Camera: Topcon TRC-NW8 · retinal fundus photograph: 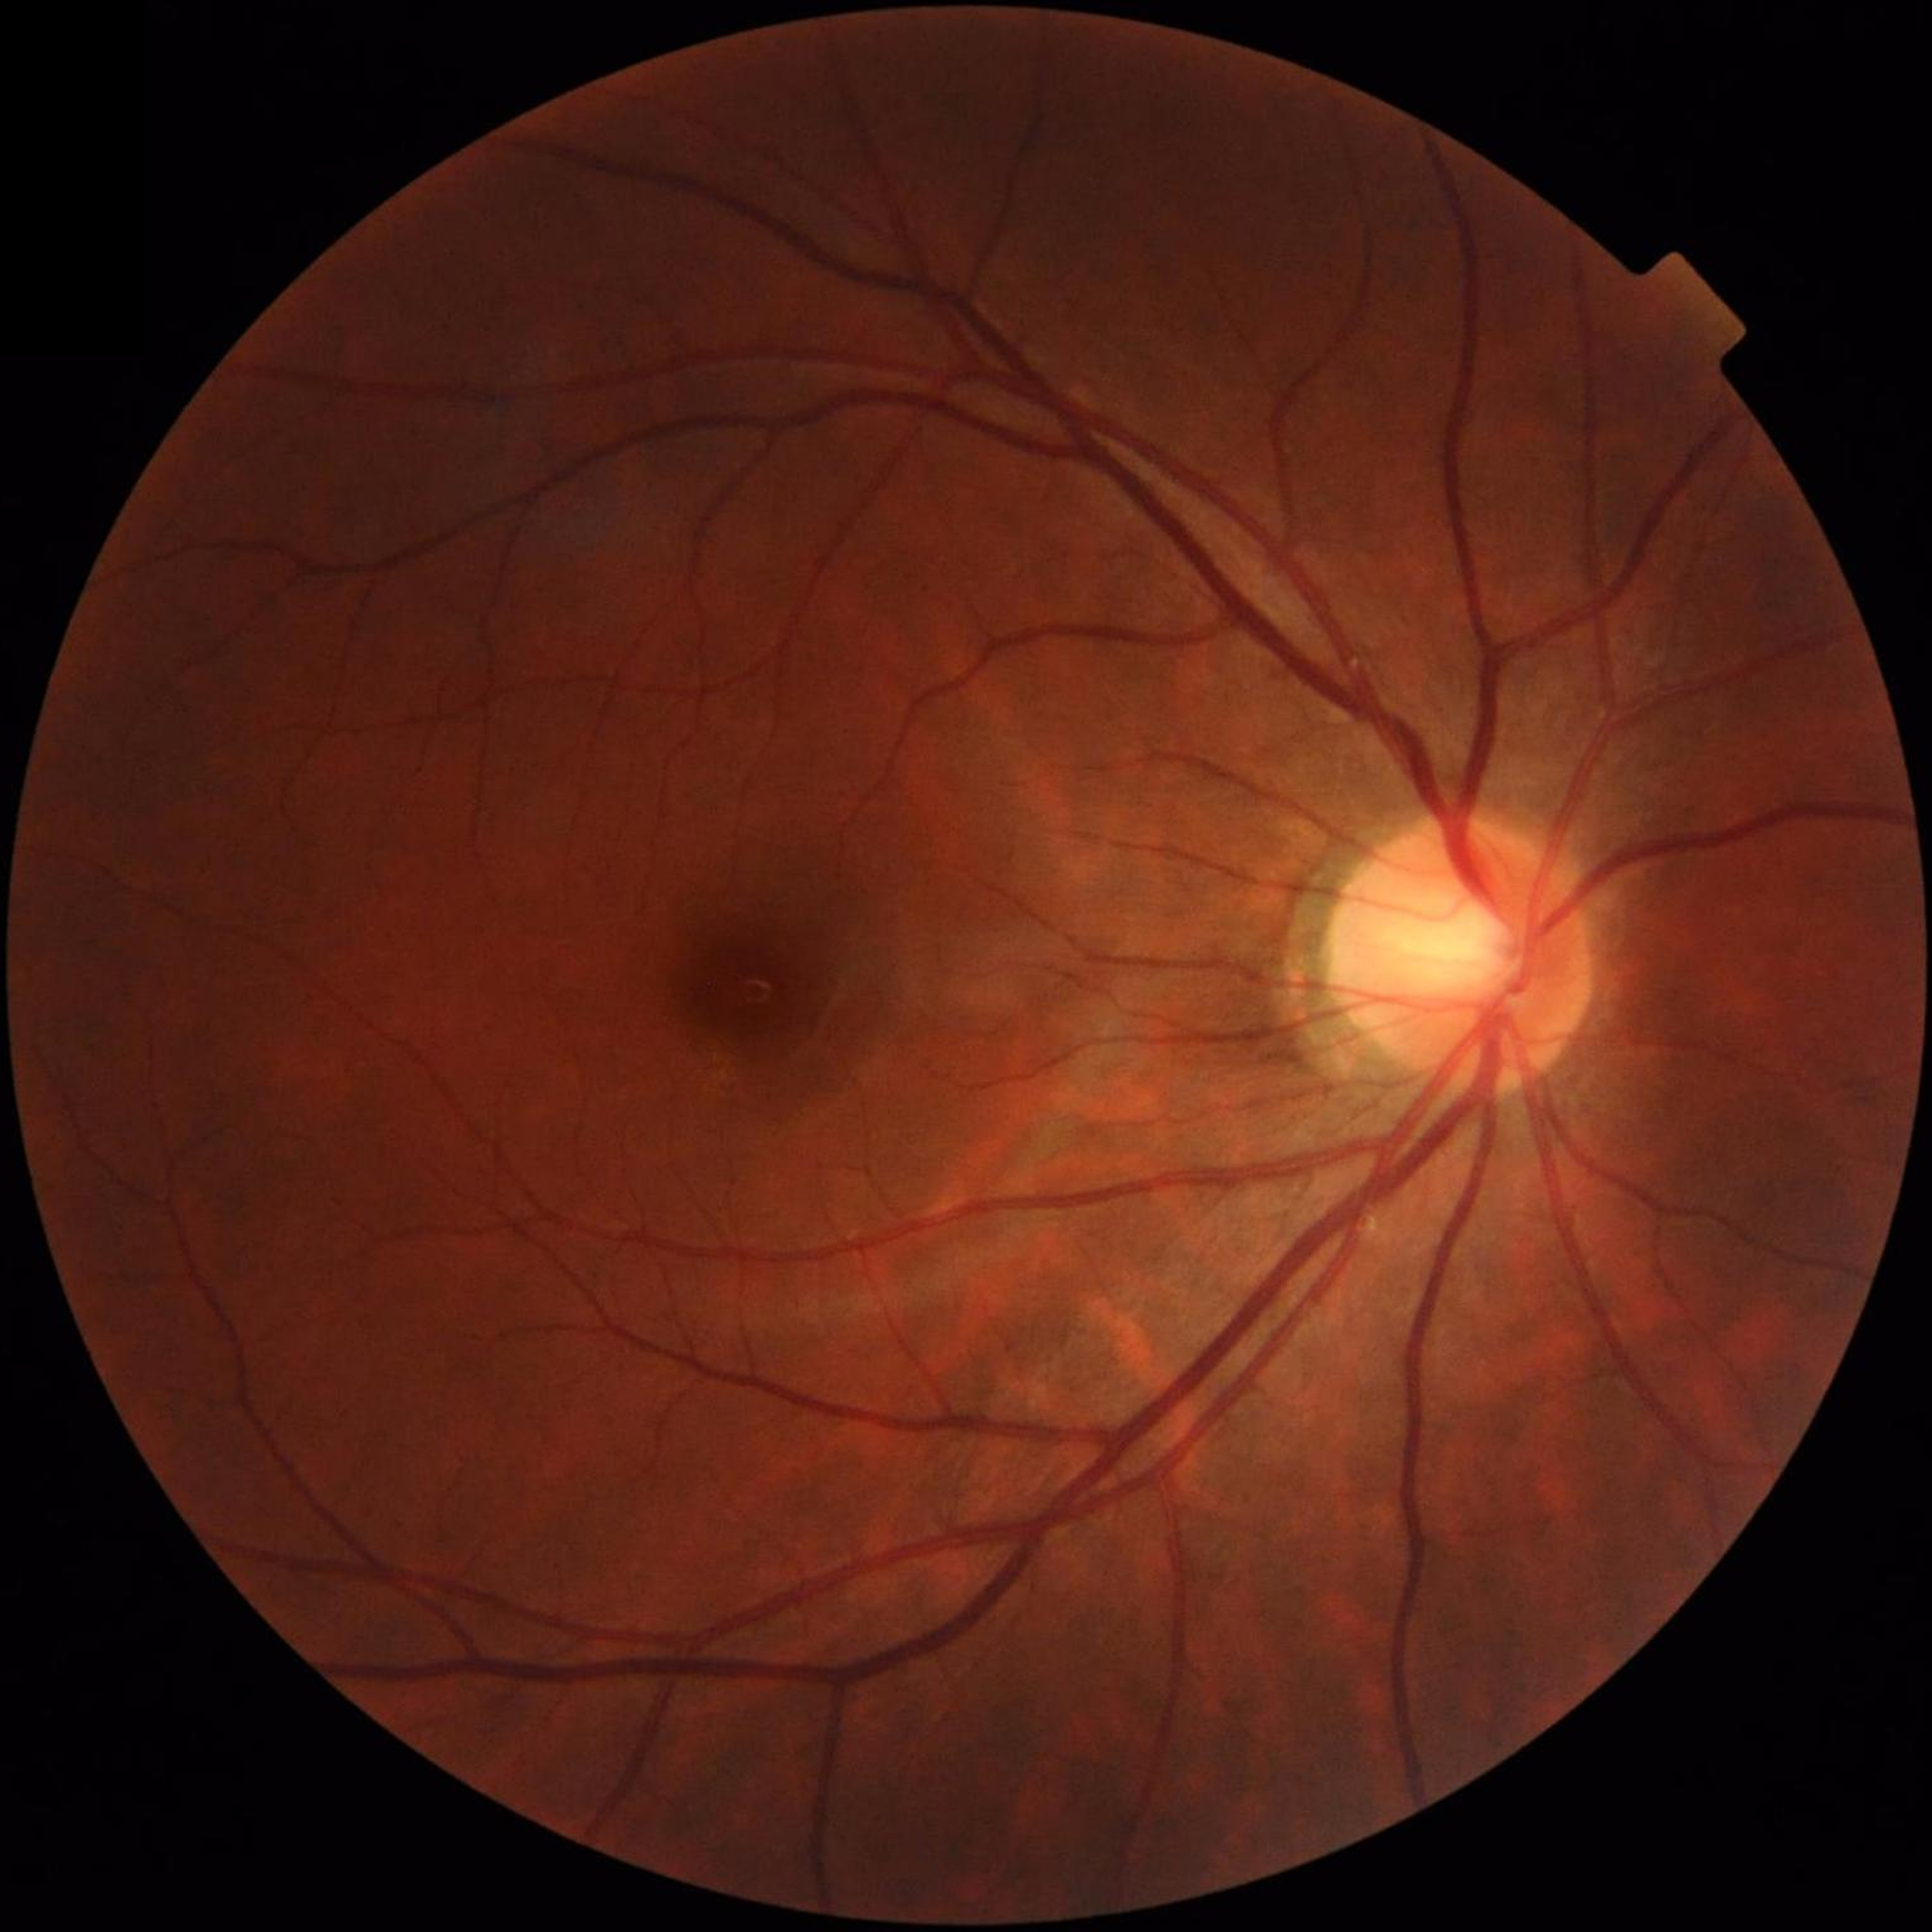 No AMD, DR, or glaucomatous findings.